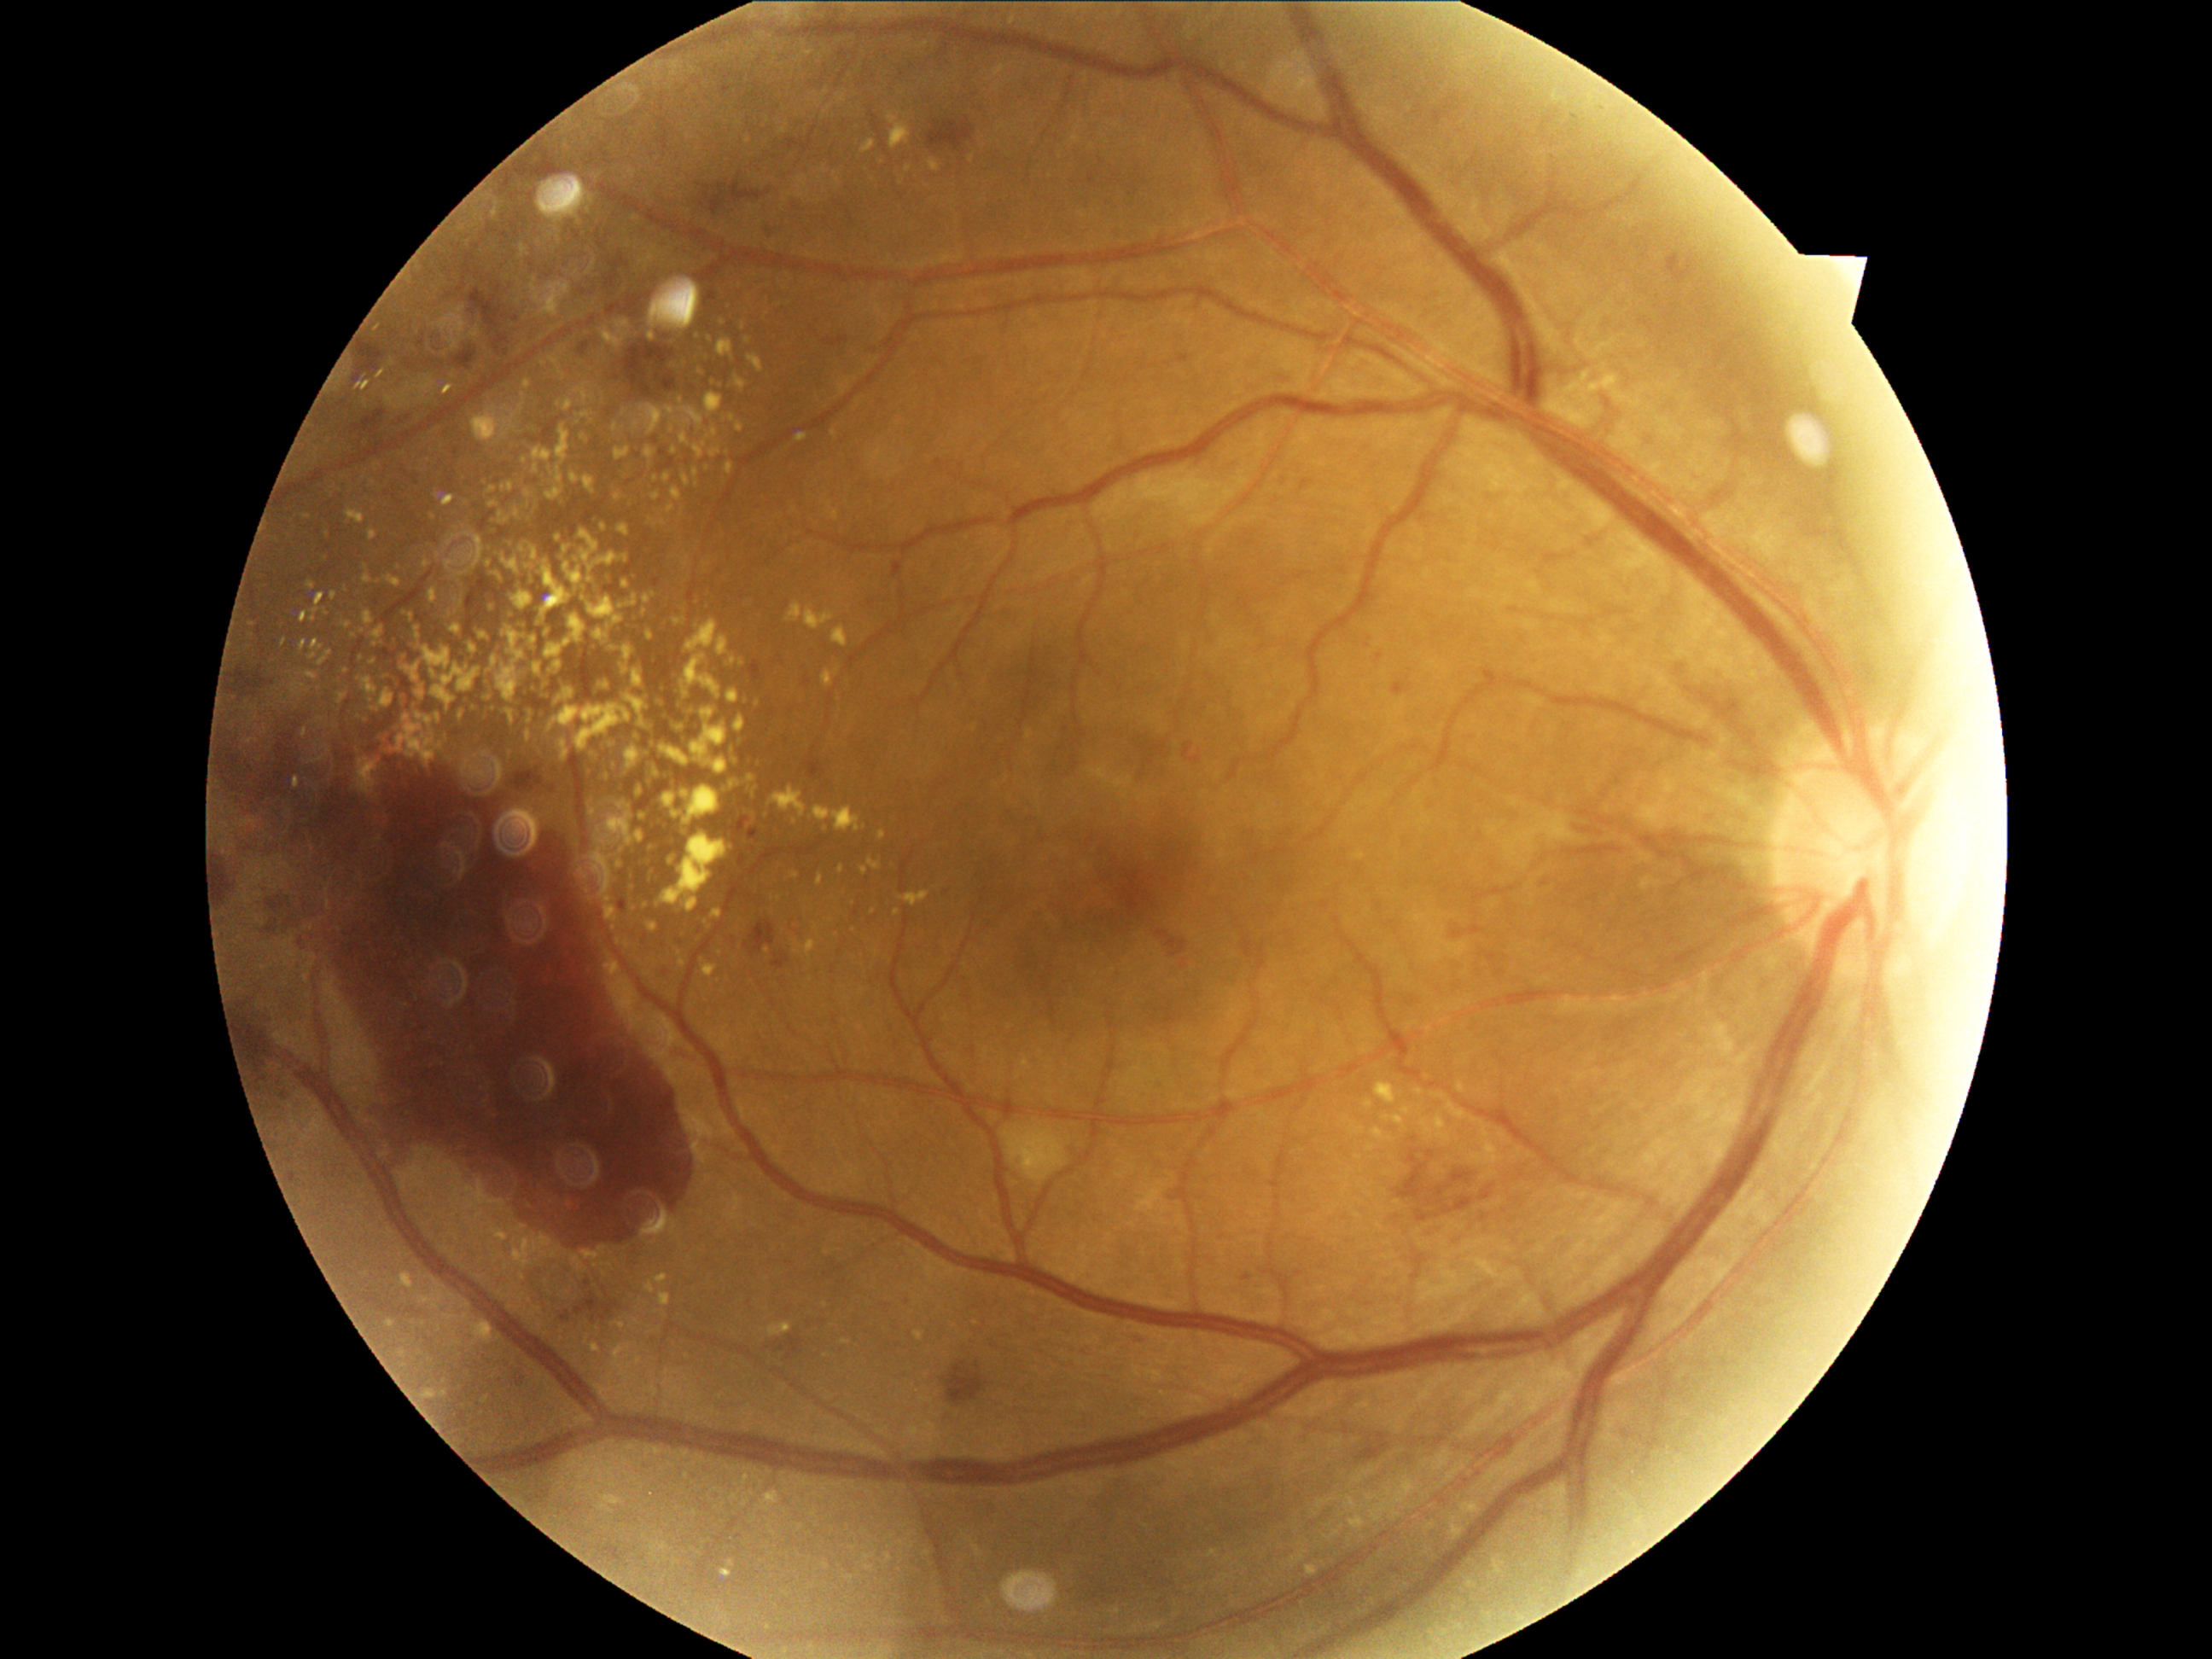

DR severity: 4/4
Lesions identified (partial list):
EXs (partial): 351:631:356:639 | 684:477:690:486 | 370:532:376:542 | 494:1230:509:1242 | 370:701:380:714 | 718:341:735:364 | 533:448:552:462 | 308:583:315:591 | 656:1274:667:1283 | 525:516:528:528 | 474:412:501:443 | 661:772:672:783
Additional small EXs near point(846, 1342) | point(489, 681) | point(810, 53) | point(732, 418) | point(650, 879) | point(327, 535) | point(418, 705)